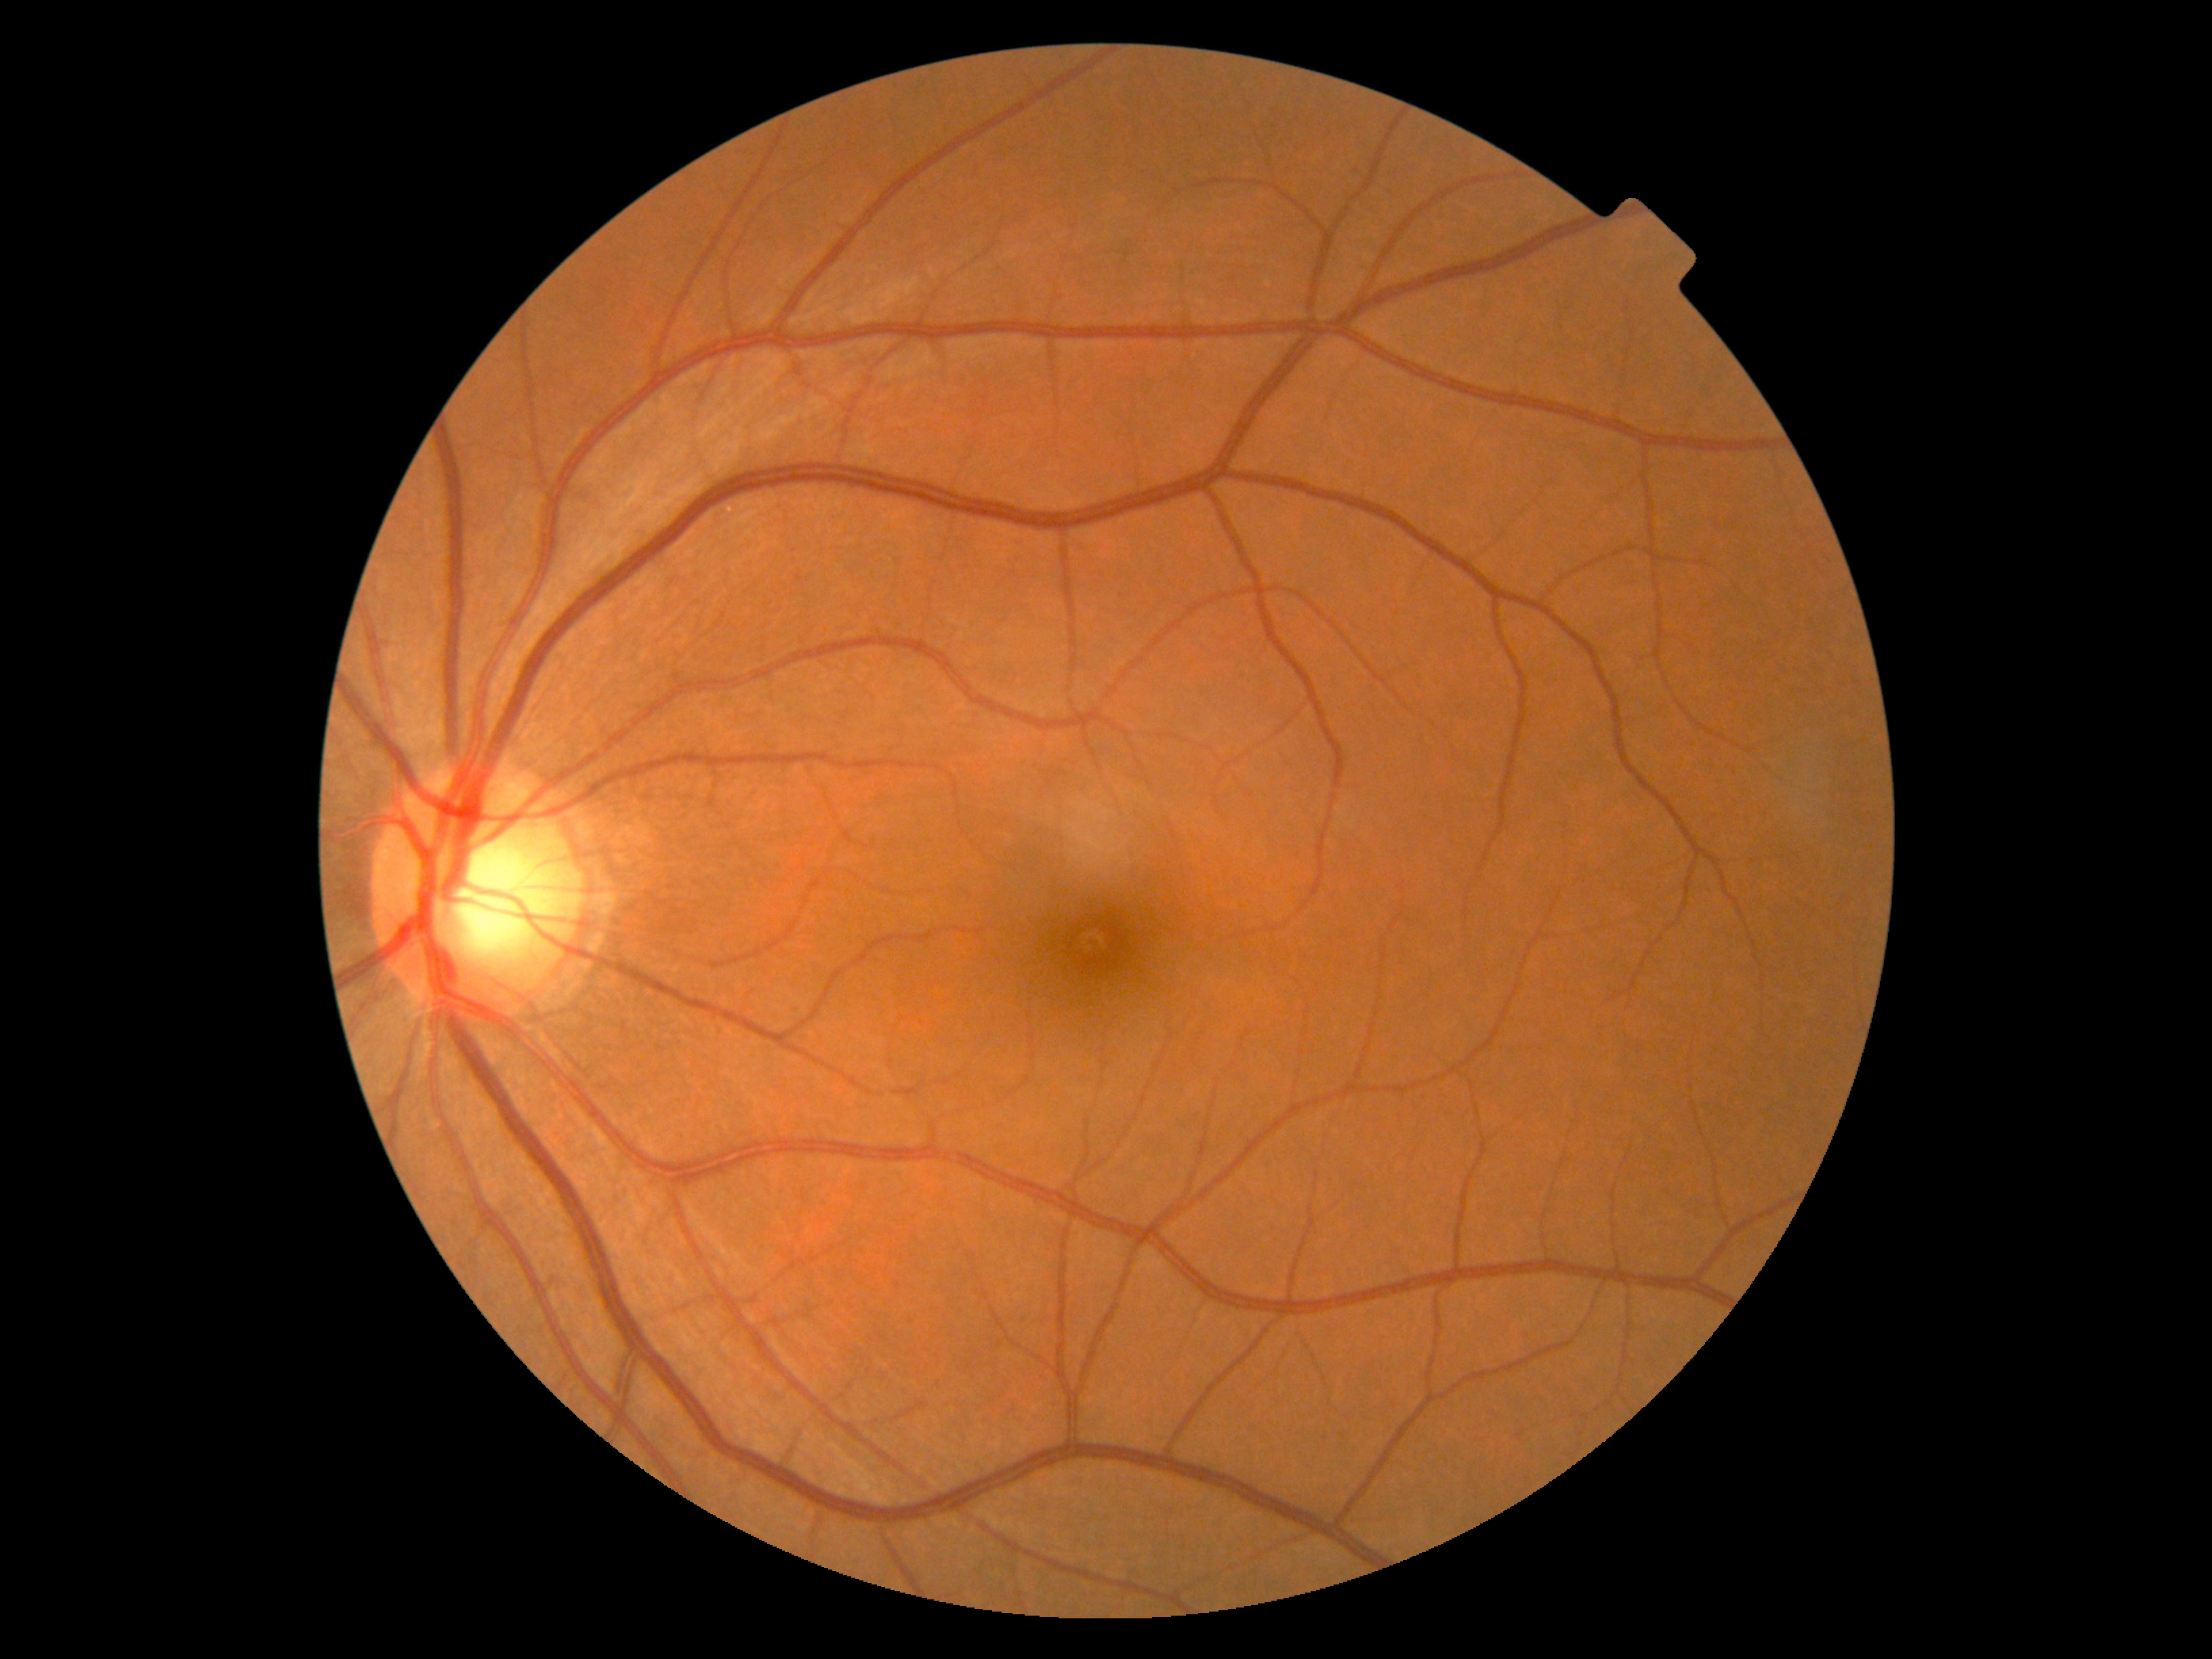

No DR findings. DR severity is grade 0 (no apparent retinopathy).